Image size 1240x1240 · infant wide-field retinal image: 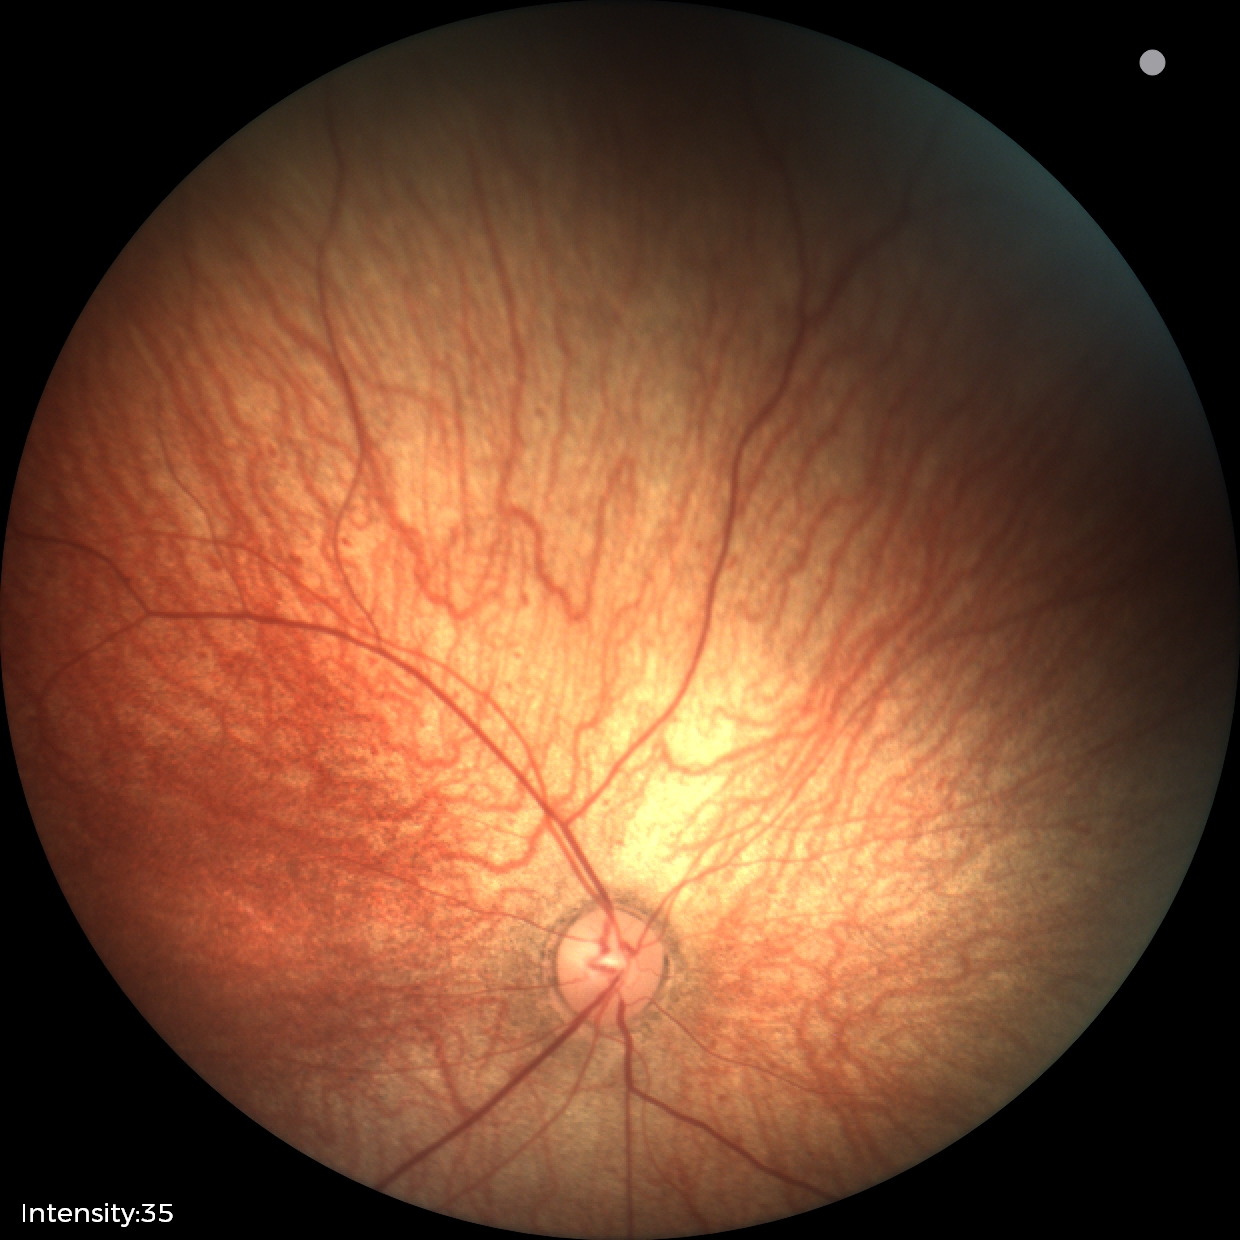

Finding = no abnormalities.